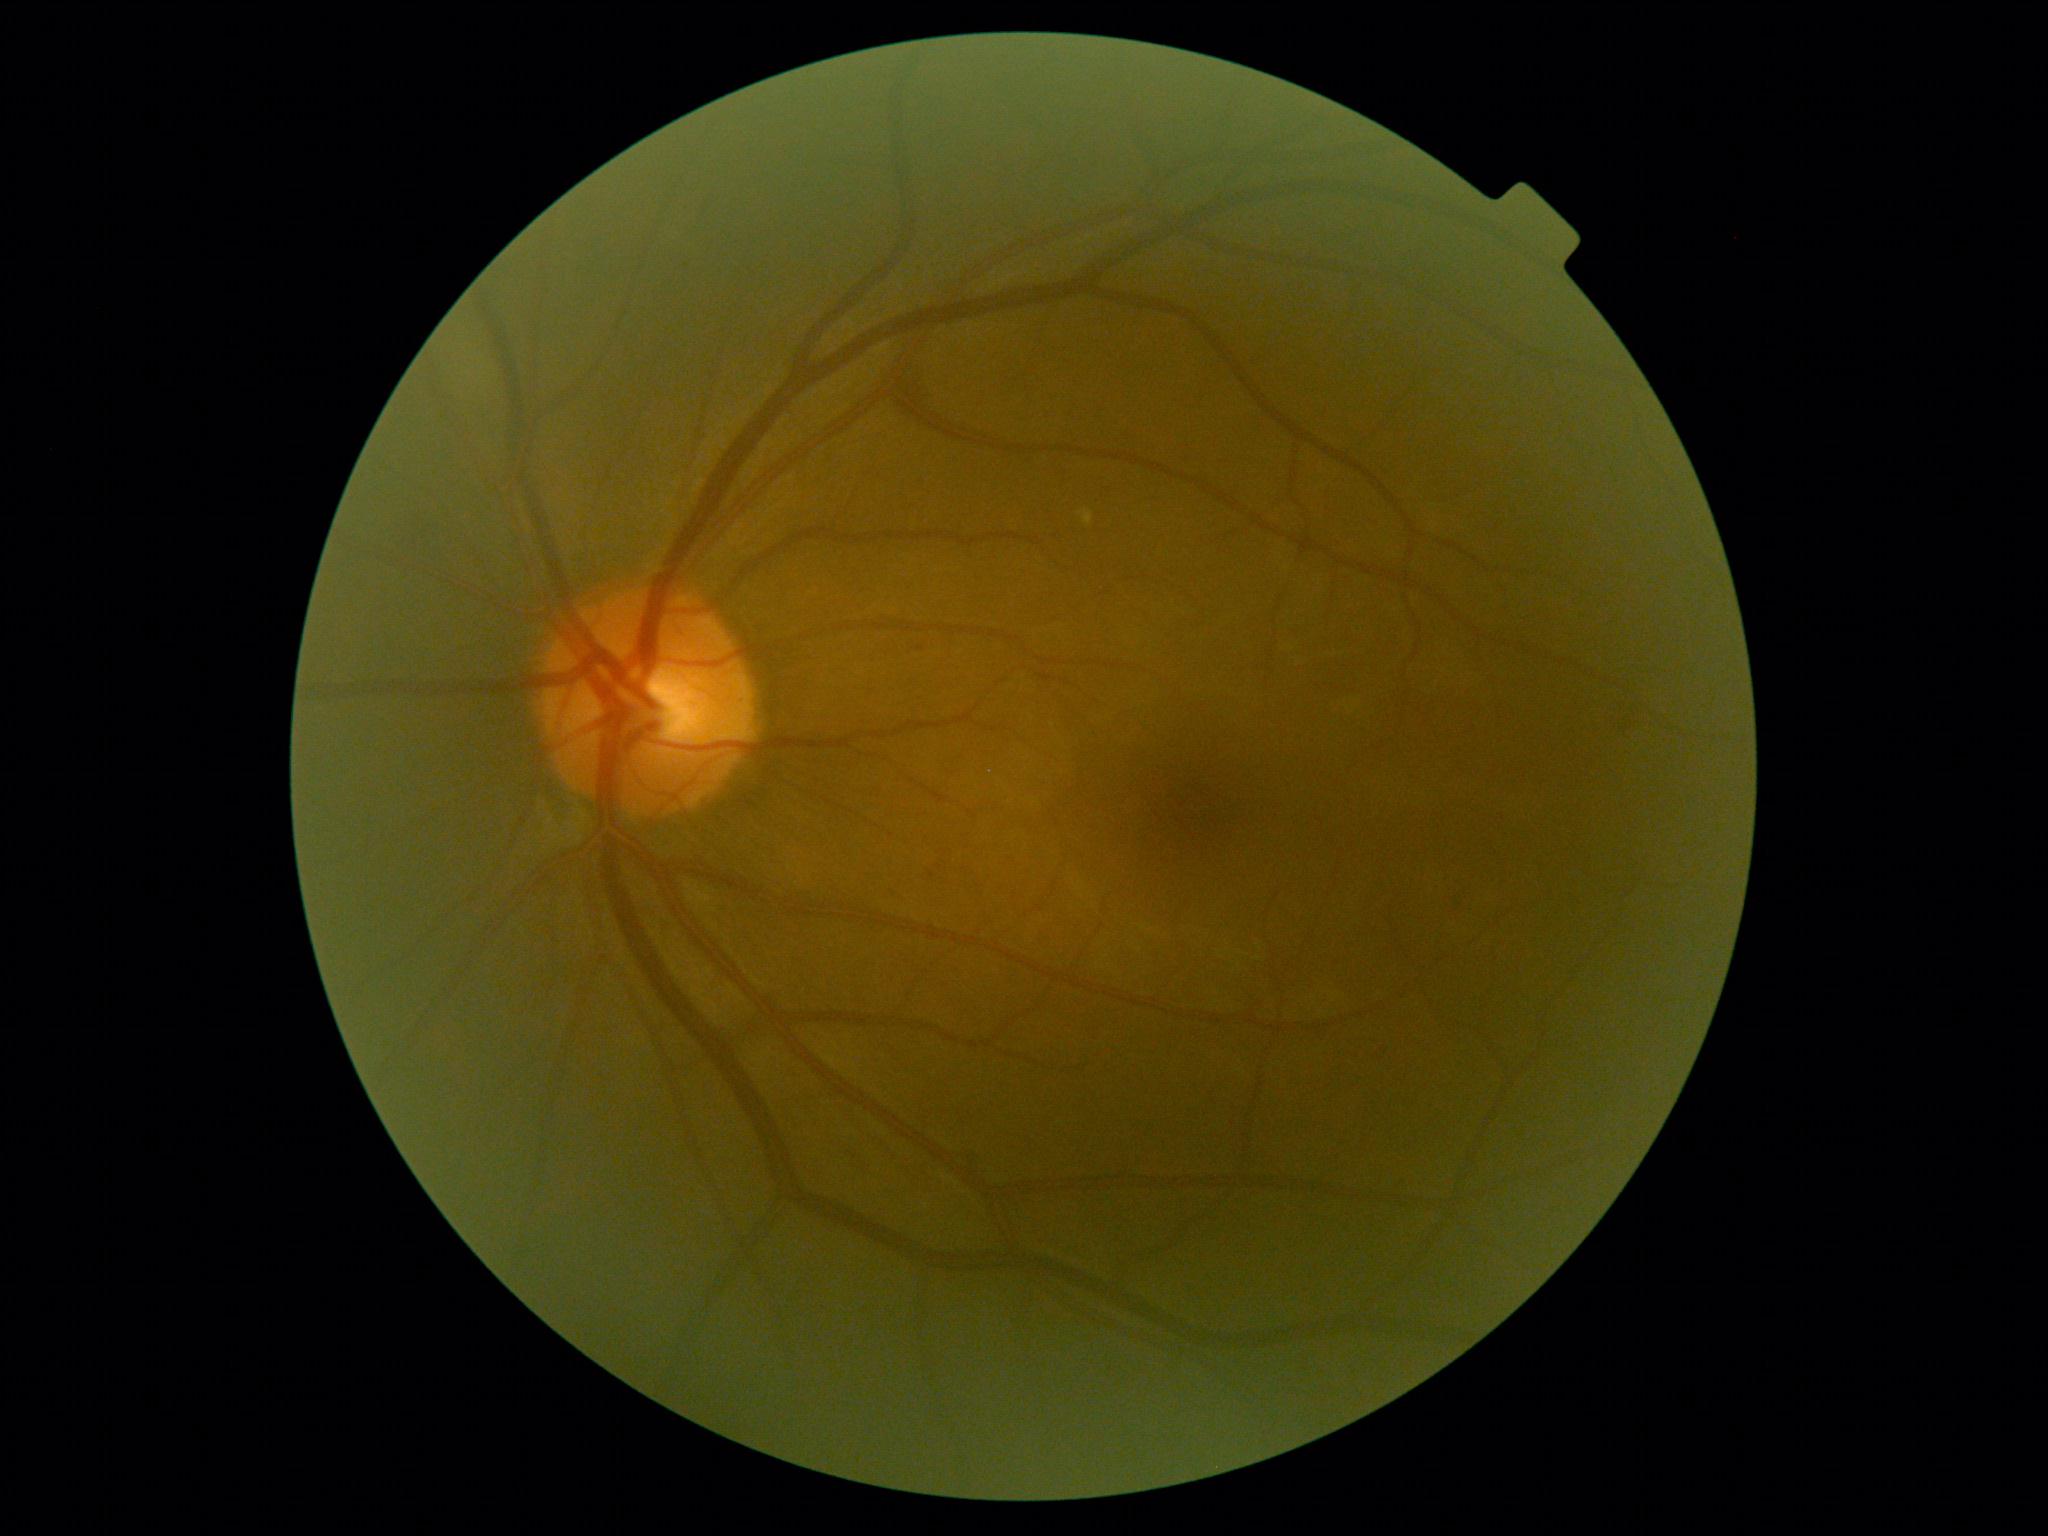

DR grade is mild NPDR (1).